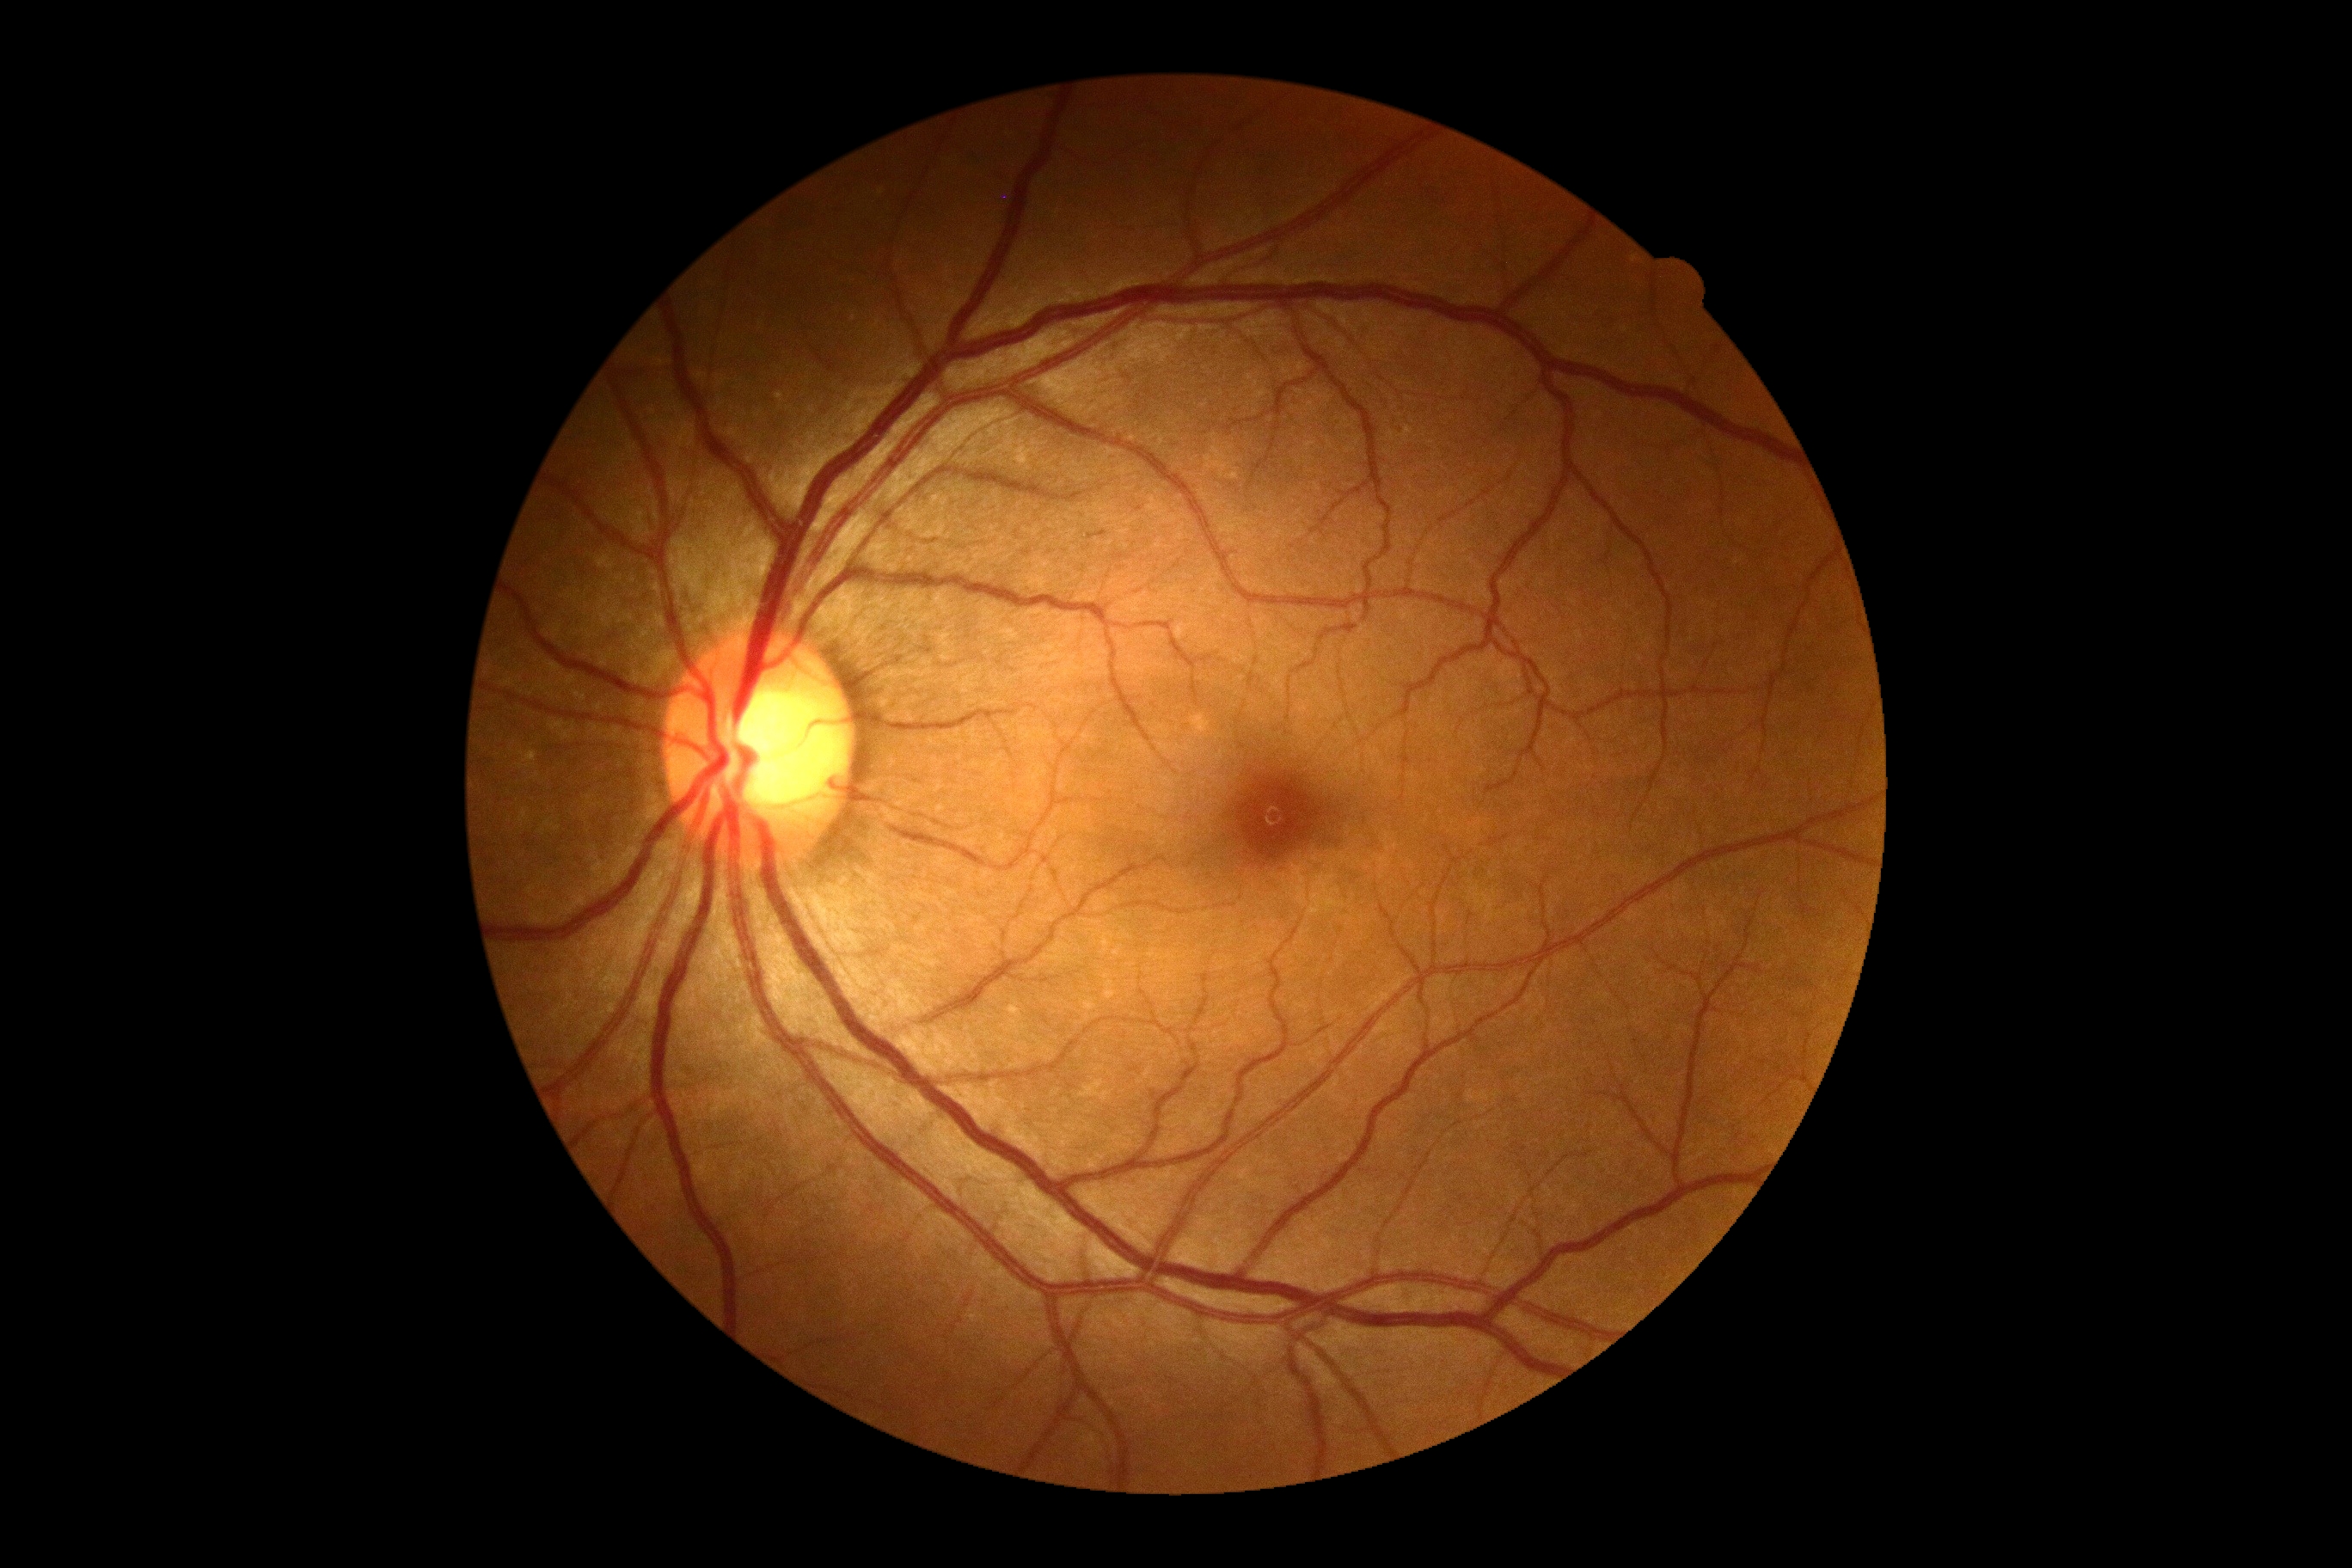

Diabetic retinopathy severity: 0/4.